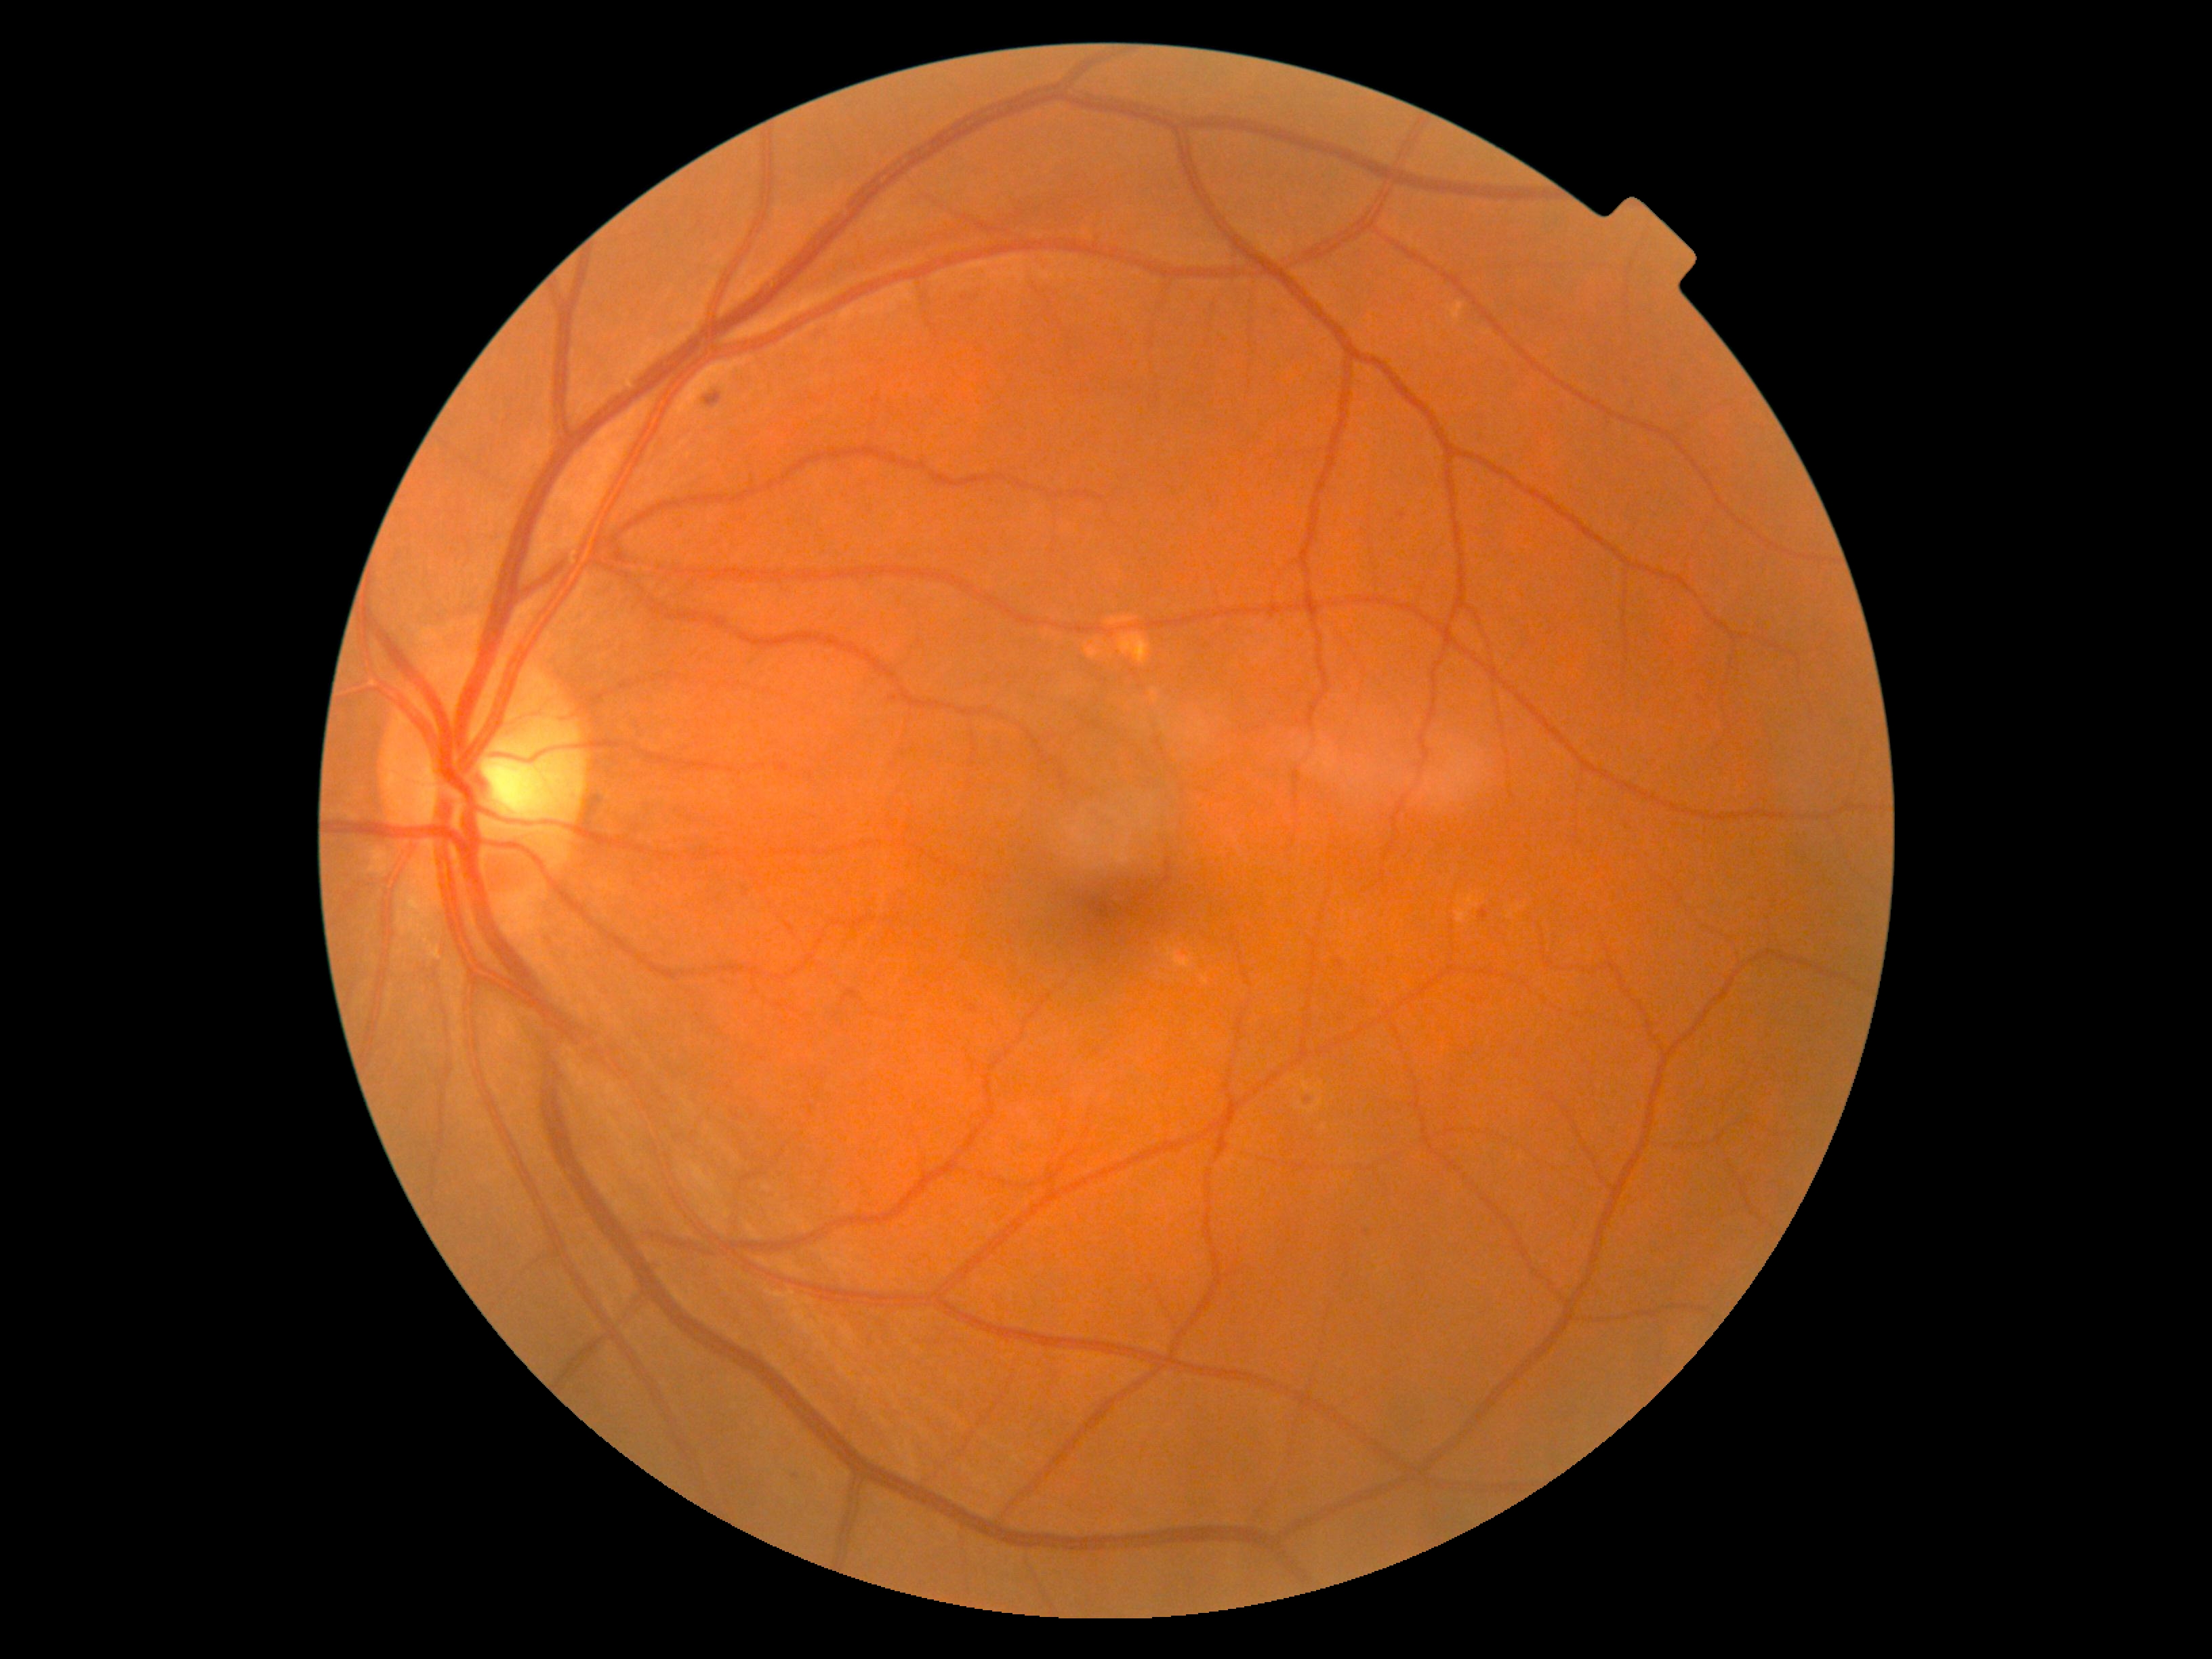

partial: true
dr_grade: 2
lesions:
  ex:
    - bbox=(1448, 302, 1465, 325)
  he:
    - bbox=(705, 392, 722, 406)
  ma:
    - bbox=(1479, 910, 1489, 920)
  ma_small_approx:
    - x=1401, y=516
    - x=974, y=1010
    - x=1311, y=1102
    - x=1340, y=963
  se: []